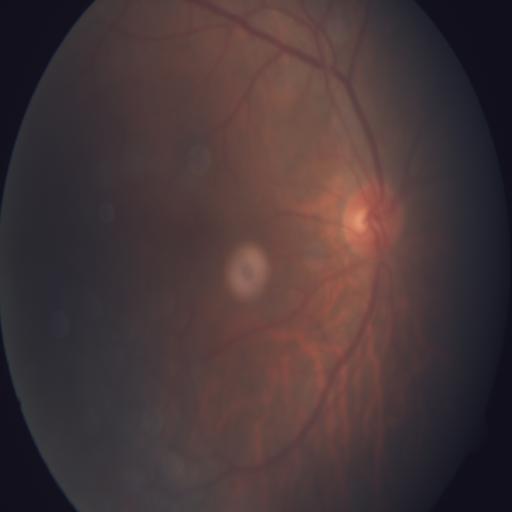 Color fundus photograph showing tessellation.